Wide-field fundus photograph from neonatal ROP screening — 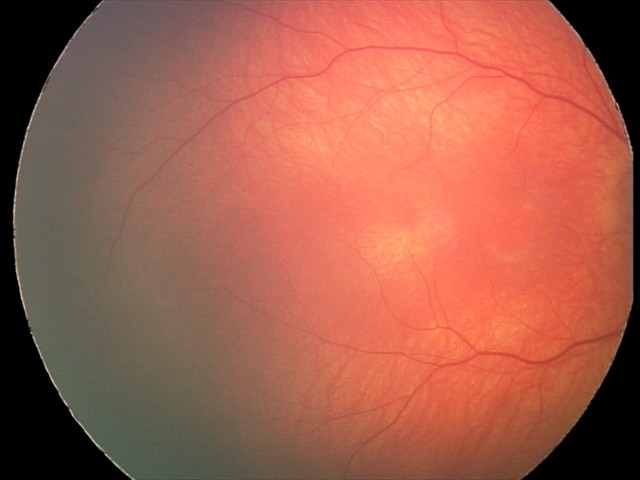
No retinal pathology identified on screening.